Non-mydriatic acquisition, 240 by 240 pixels — 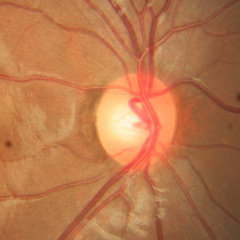
There is evidence of no glaucomatous findings.